CFP. 2352 by 1568 pixels: 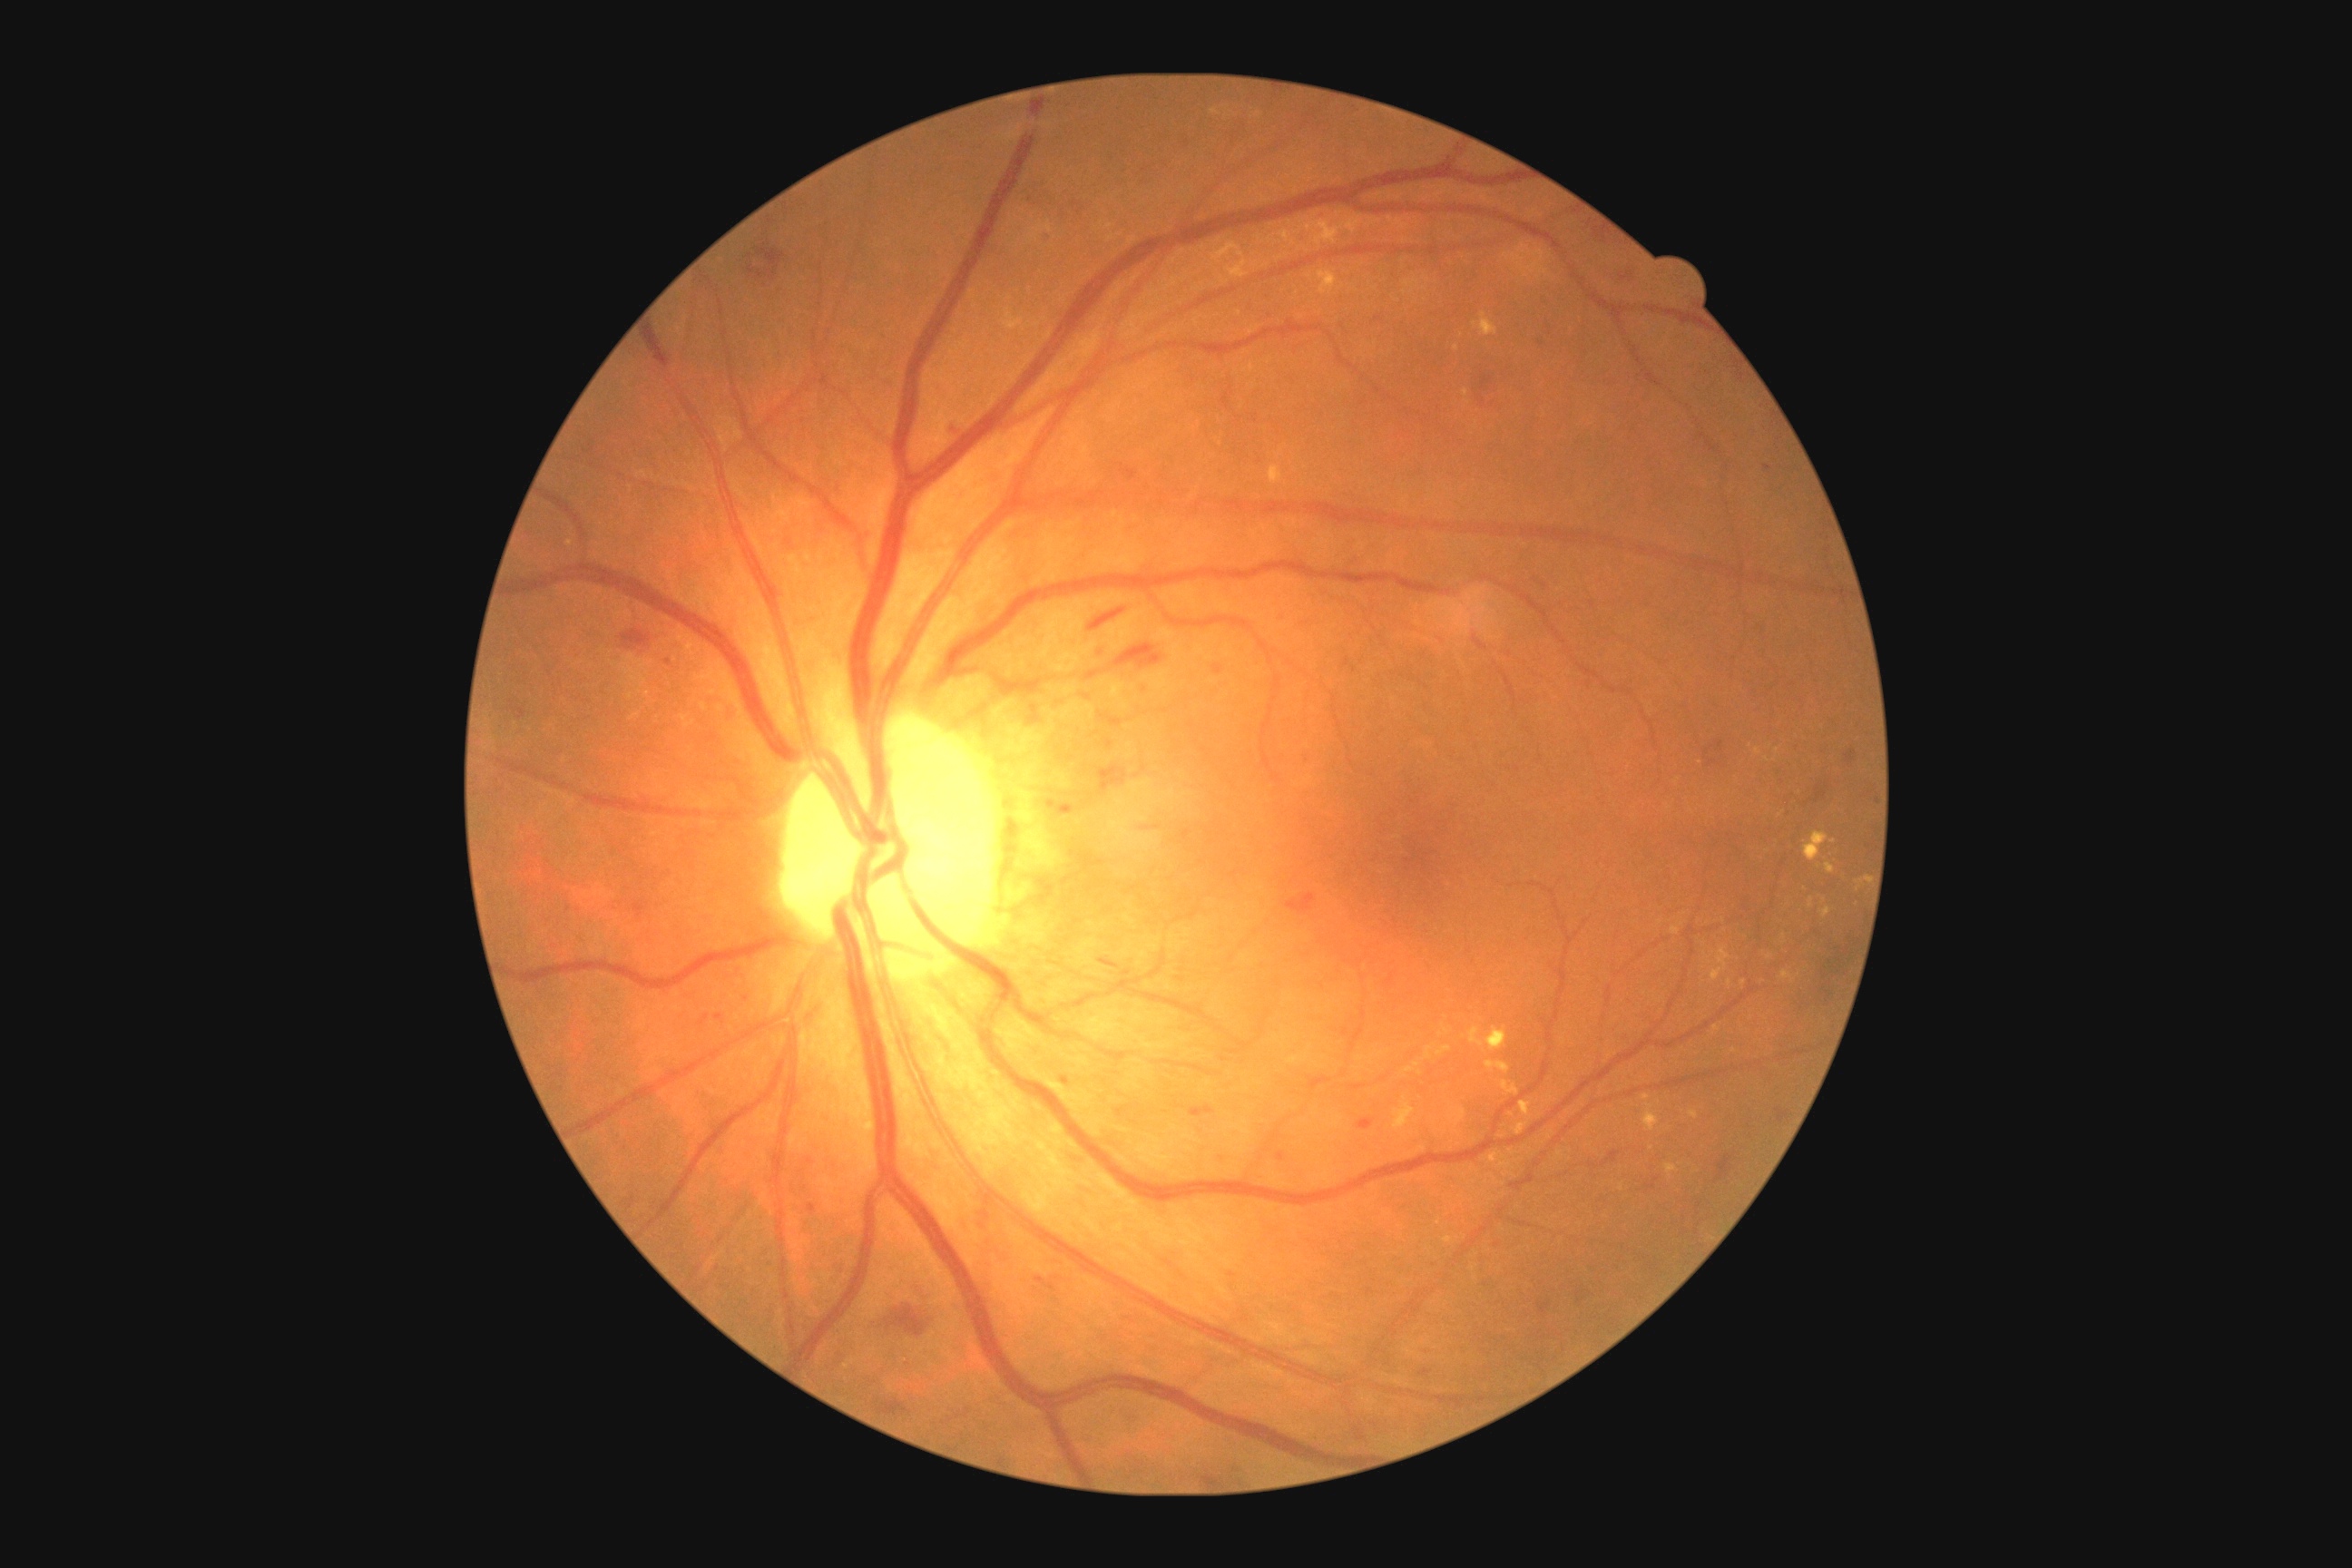

Diabetic retinopathy grade: 2 (moderate NPDR)
Lesions identified (partial list):
hard exudates (more not shown): rect(1689, 1112, 1698, 1119); rect(1211, 244, 1248, 279); rect(1269, 466, 1284, 484); rect(1665, 1164, 1680, 1177); rect(1825, 863, 1836, 874); rect(1810, 899, 1814, 908); rect(1710, 948, 1730, 981); rect(1671, 926, 1680, 936); rect(1643, 1104, 1660, 1132); rect(1514, 1124, 1527, 1137); rect(1406, 1068, 1415, 1073)
Hard exudates (small, approximate centers) near (x=1420, y=1073); (x=1475, y=325); (x=1767, y=759); (x=1834, y=841); (x=1456, y=348)
hemorrhages (more not shown): rect(1095, 643, 1110, 660); rect(1716, 741, 1723, 750); rect(1061, 803, 1070, 814); rect(1023, 190, 1035, 204); rect(1046, 801, 1055, 807); rect(1115, 643, 1164, 669); rect(946, 420, 968, 438); rect(1215, 1153, 1226, 1166); rect(808, 1204, 816, 1213); rect(622, 629, 652, 647); rect(516, 709, 527, 720); rect(1088, 609, 1126, 632); rect(1816, 785, 1827, 801)
Hemorrhages (small, approximate centers) near (x=747, y=999); (x=1768, y=468)